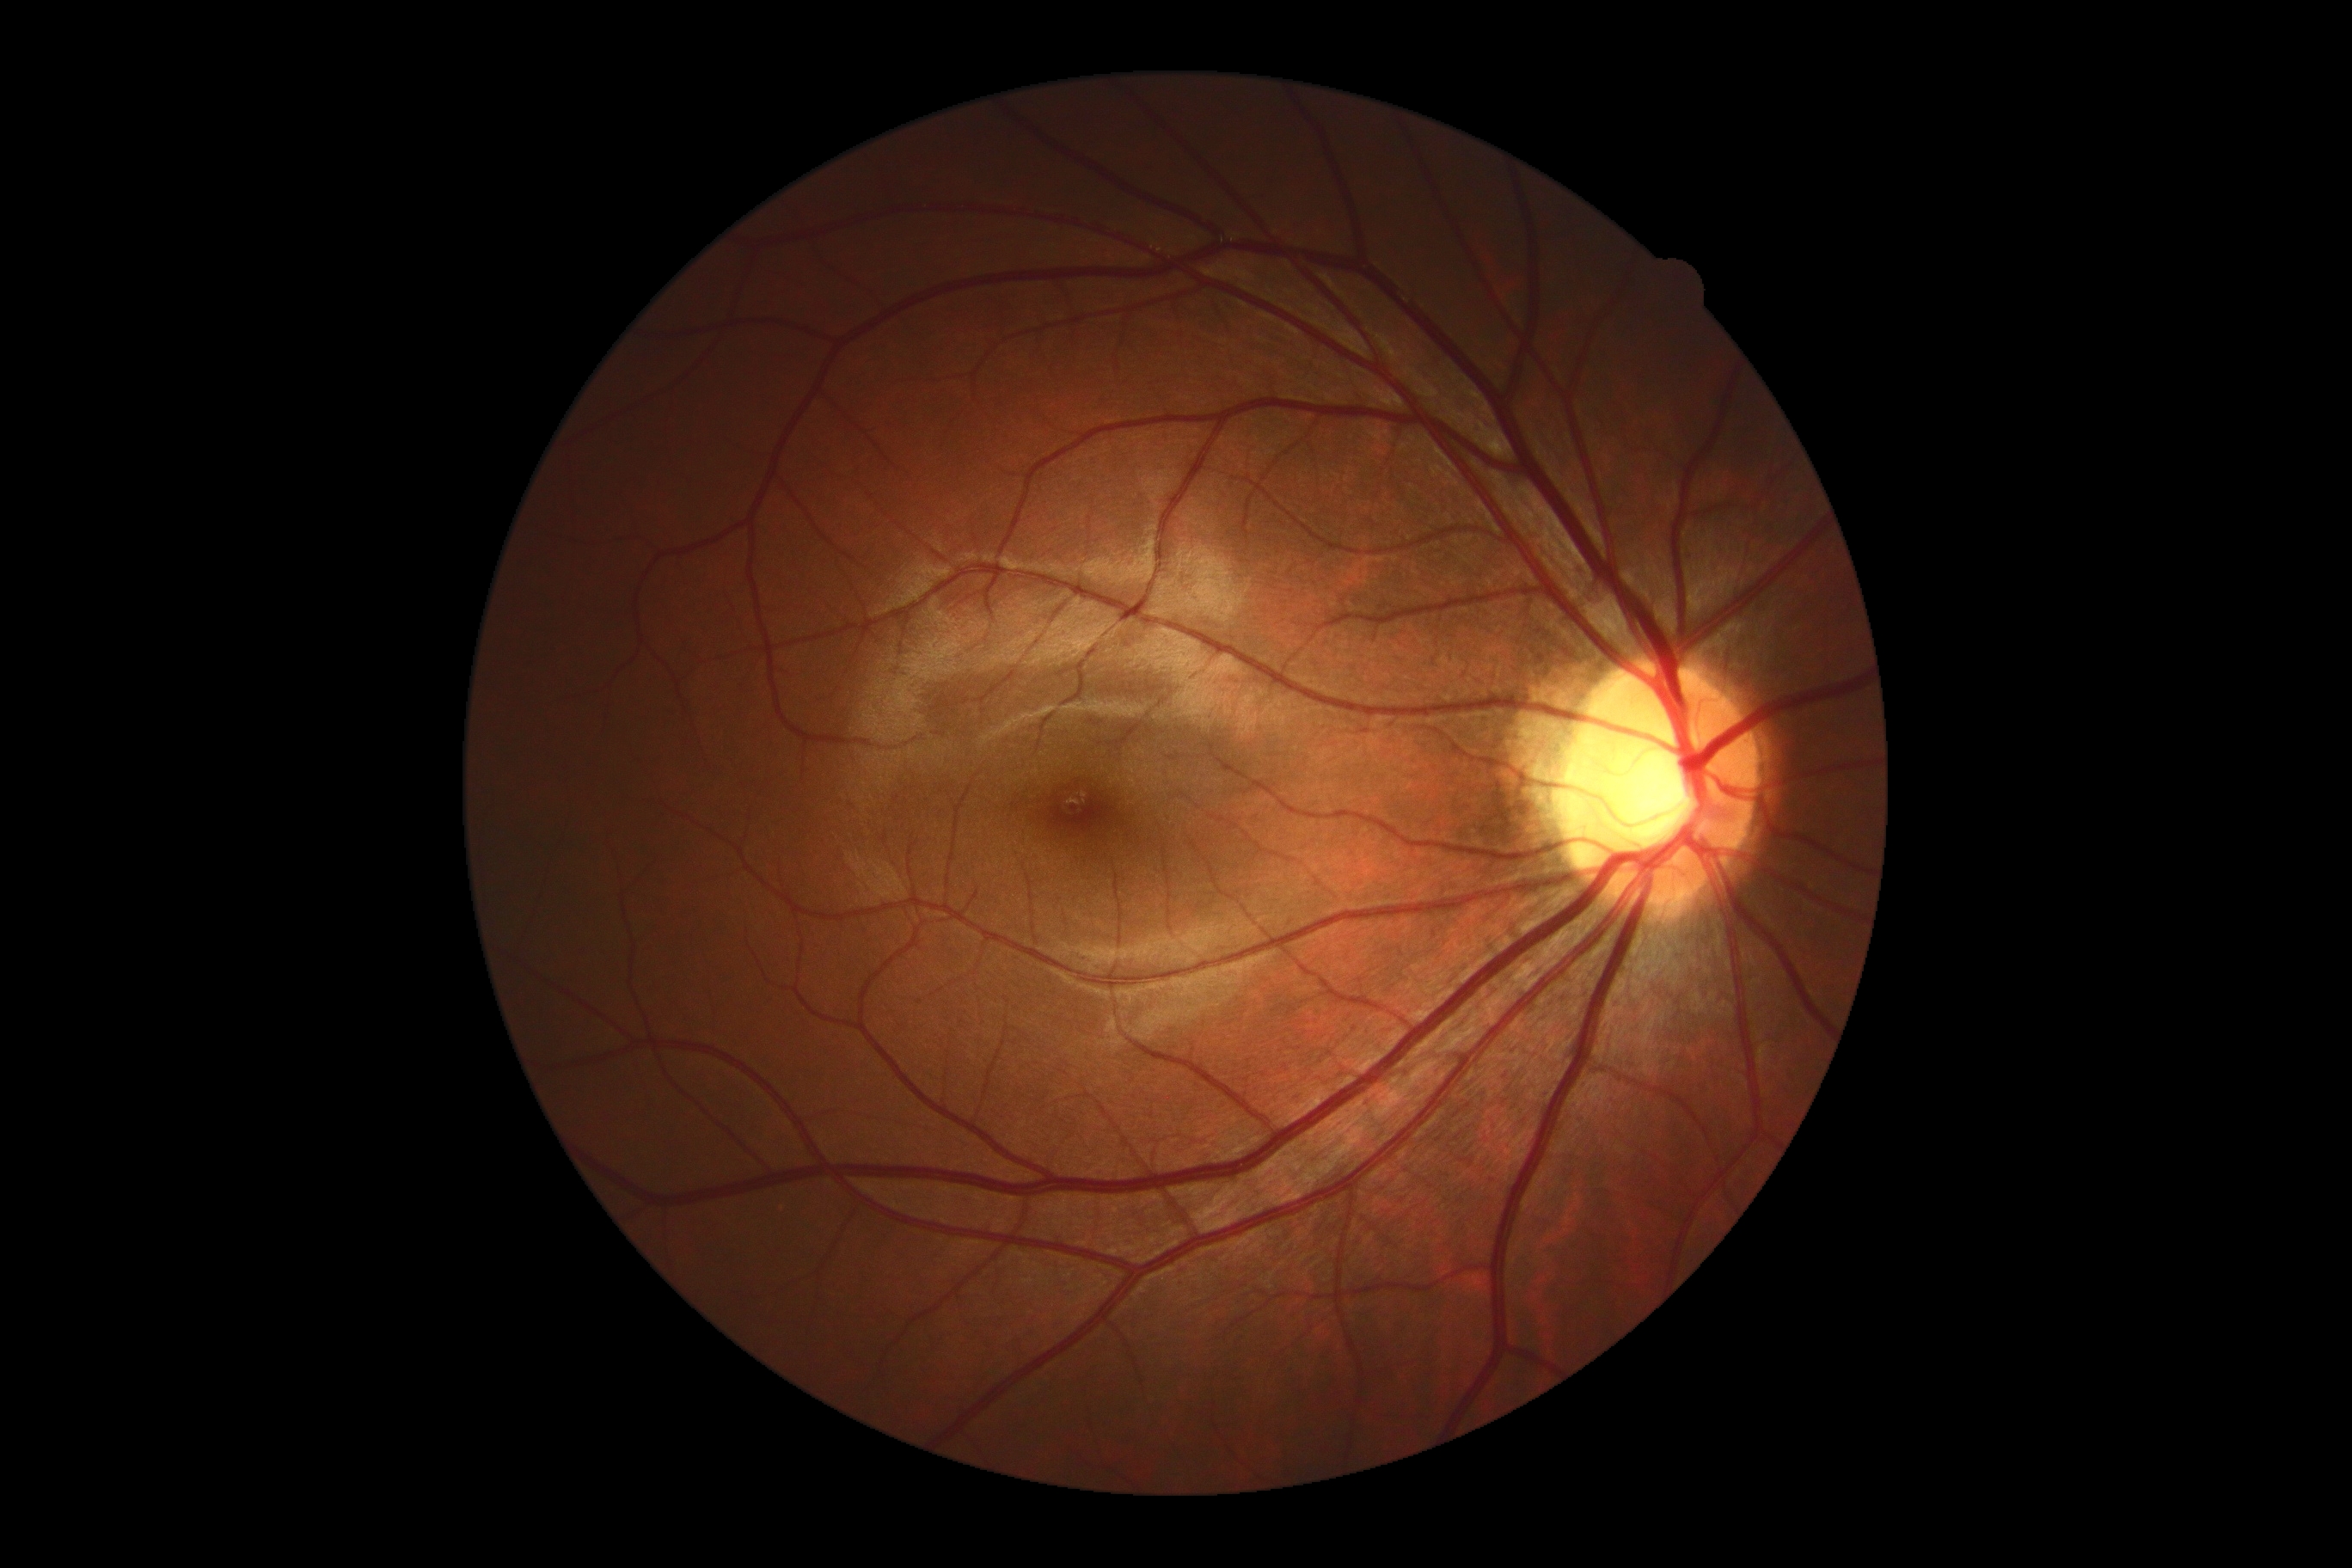

No DR findings.
DR stage: 0/4 — no visible signs of diabetic retinopathy.